No pharmacologic dilation. 848 x 848 pixels
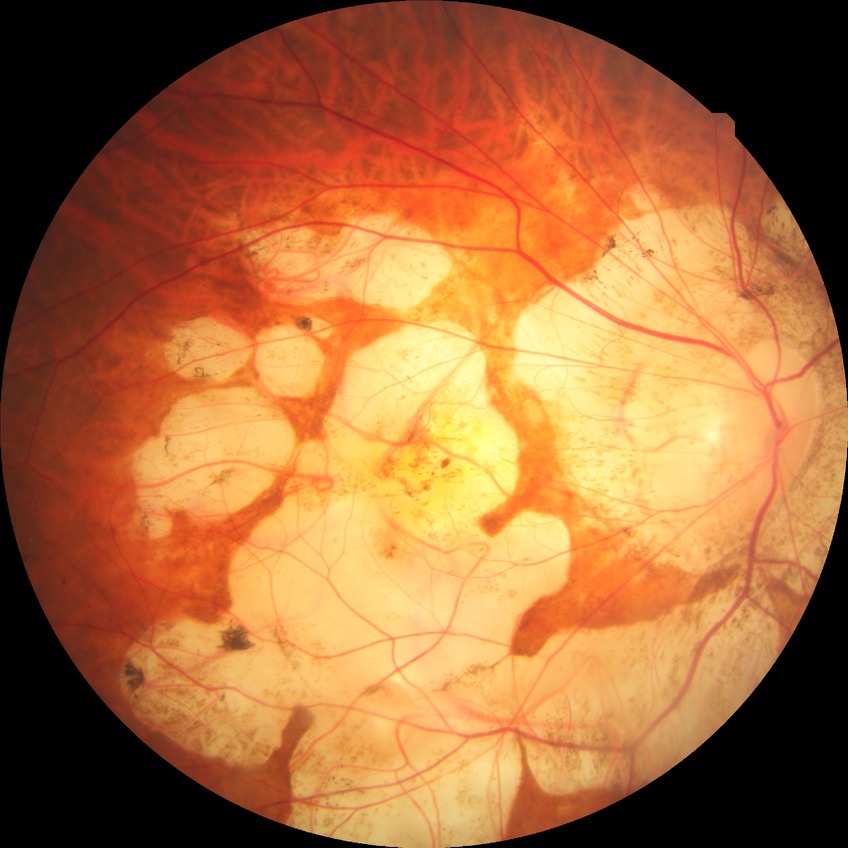 Diabetic retinopathy (DR): NDR (no diabetic retinopathy).